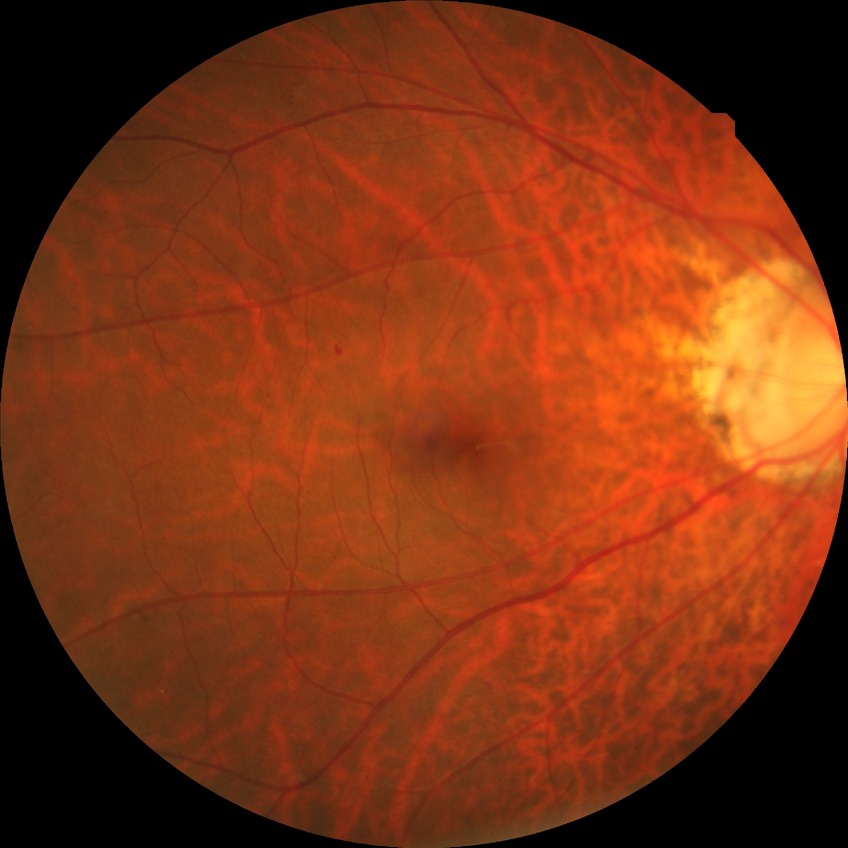
  davis_grade: SDR (simple diabetic retinopathy)